Color fundus photograph · field includes the optic disc and macula: 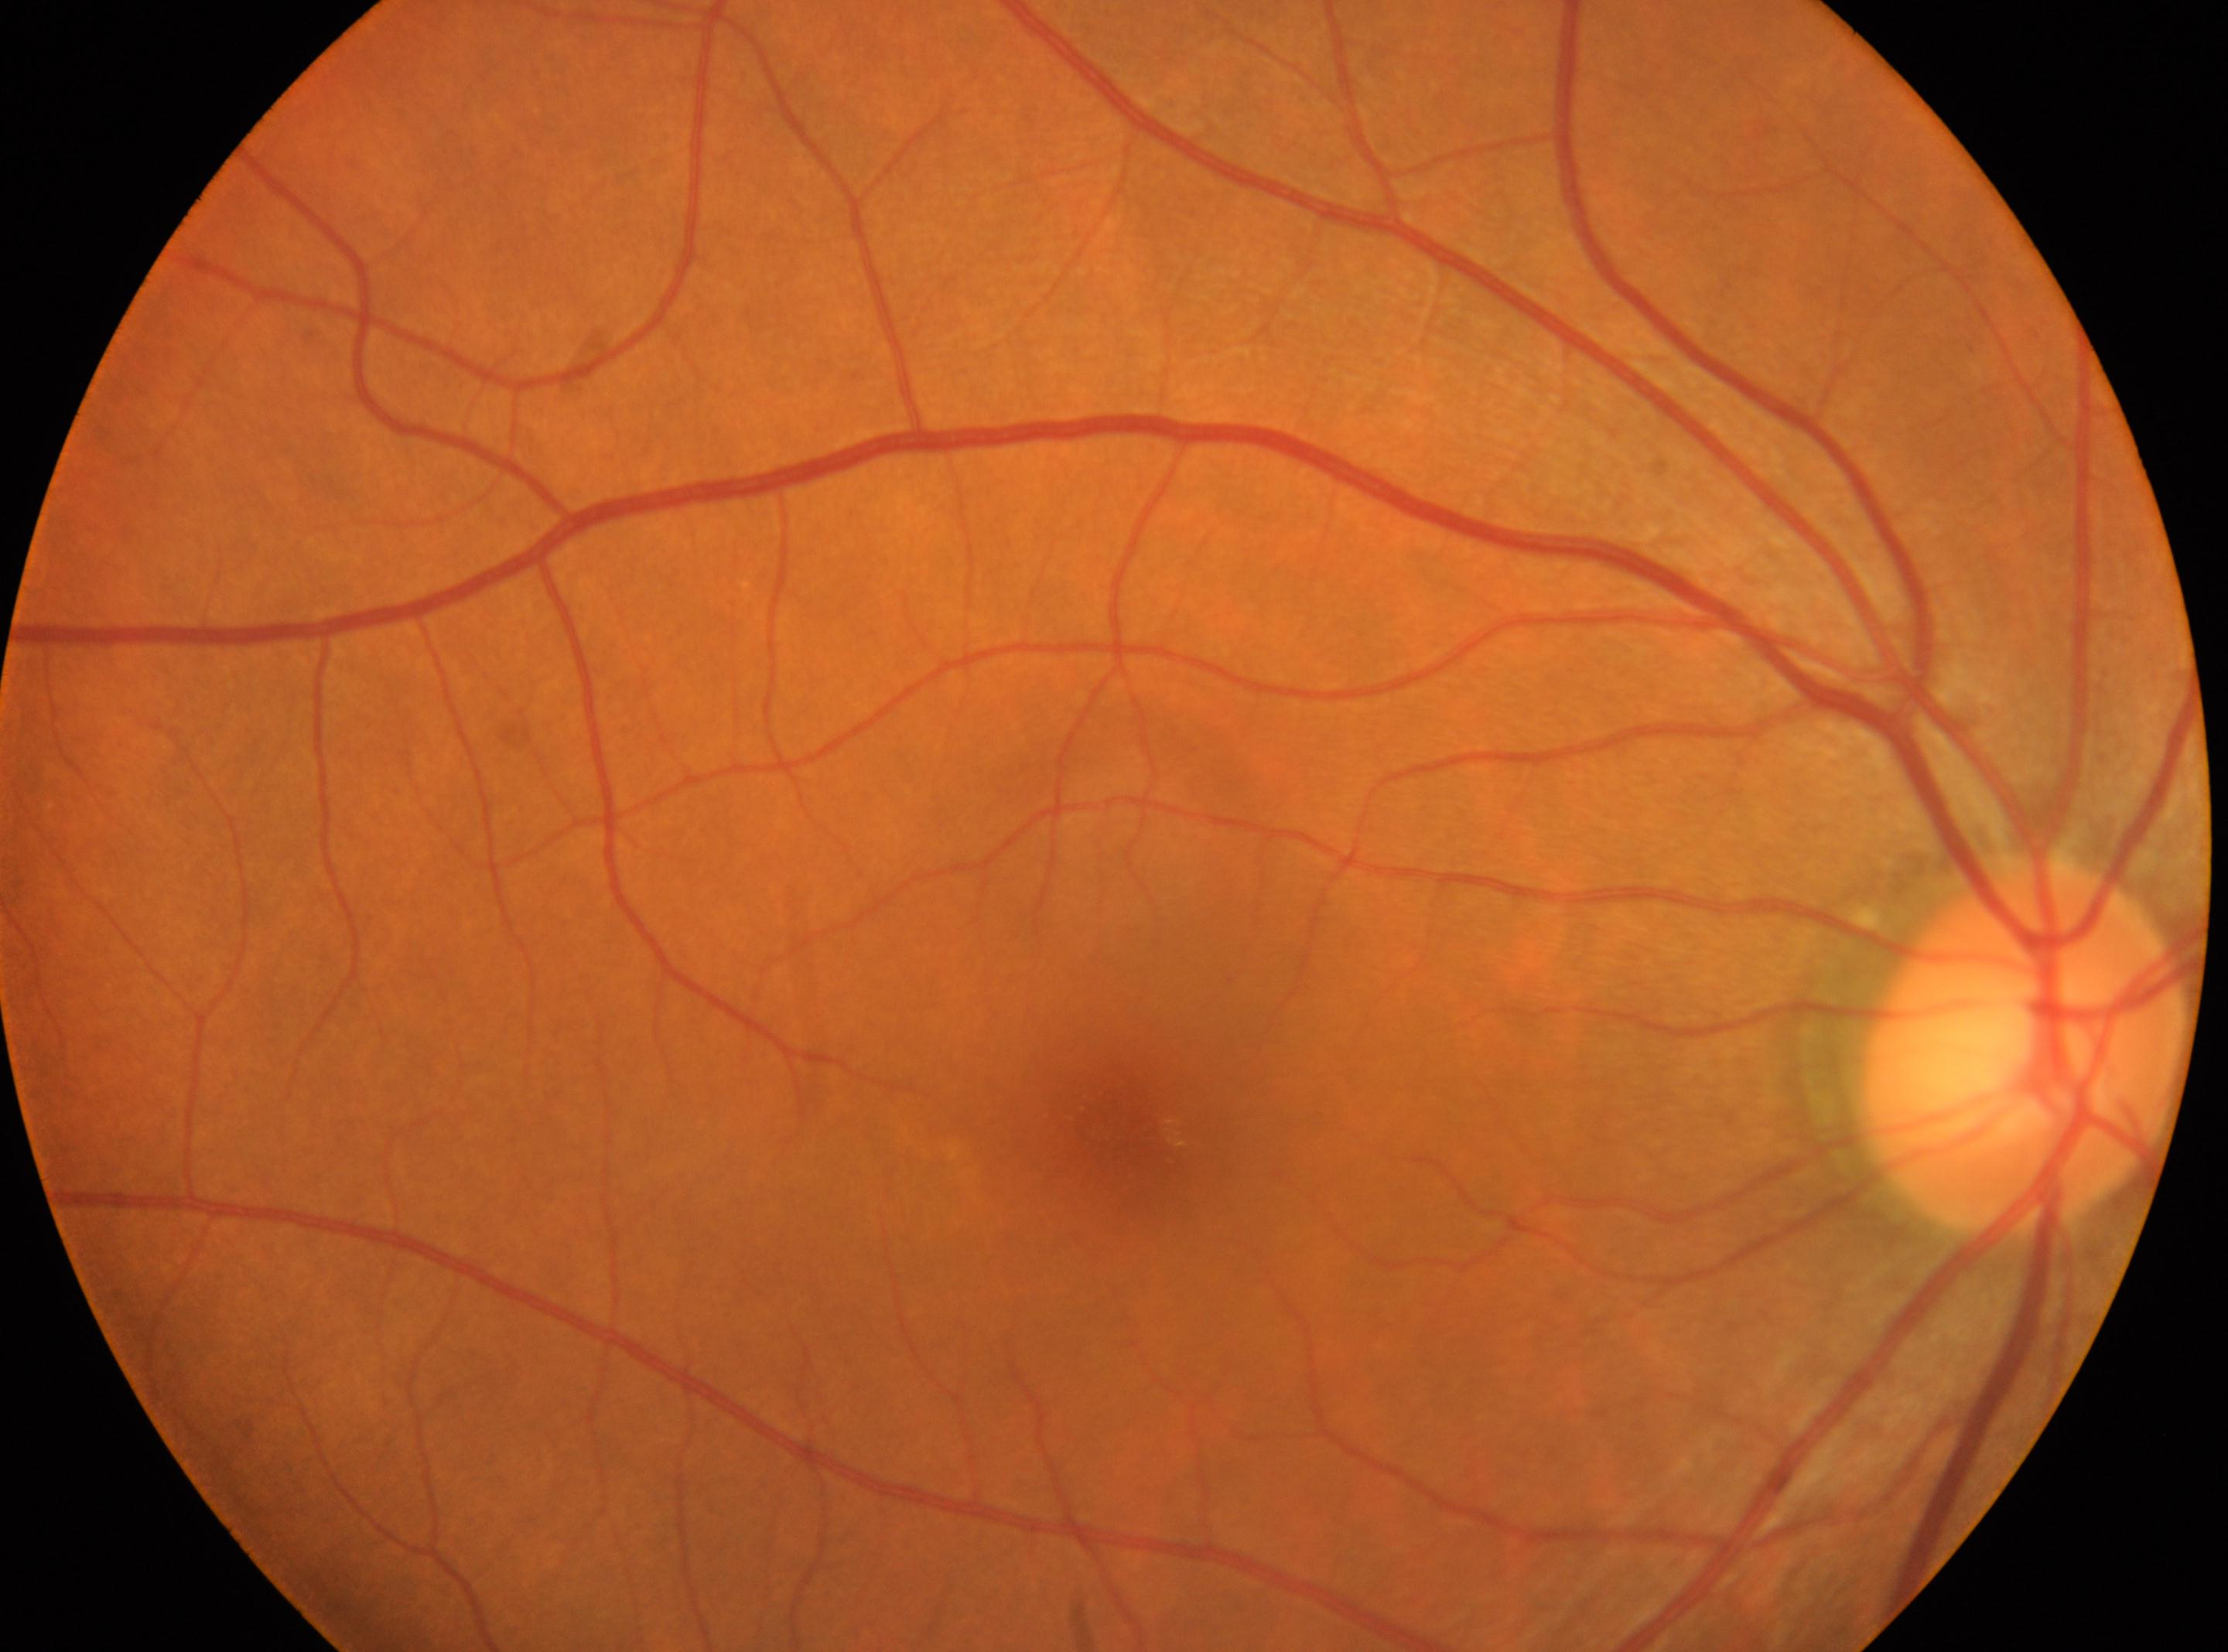

eye: right eye
optic_disc: (x: 2020, y: 1050)
dr_grade: 0
fovea: (x: 1133, y: 1137)